Camera: NIDEK AFC-230. Fundus photo:
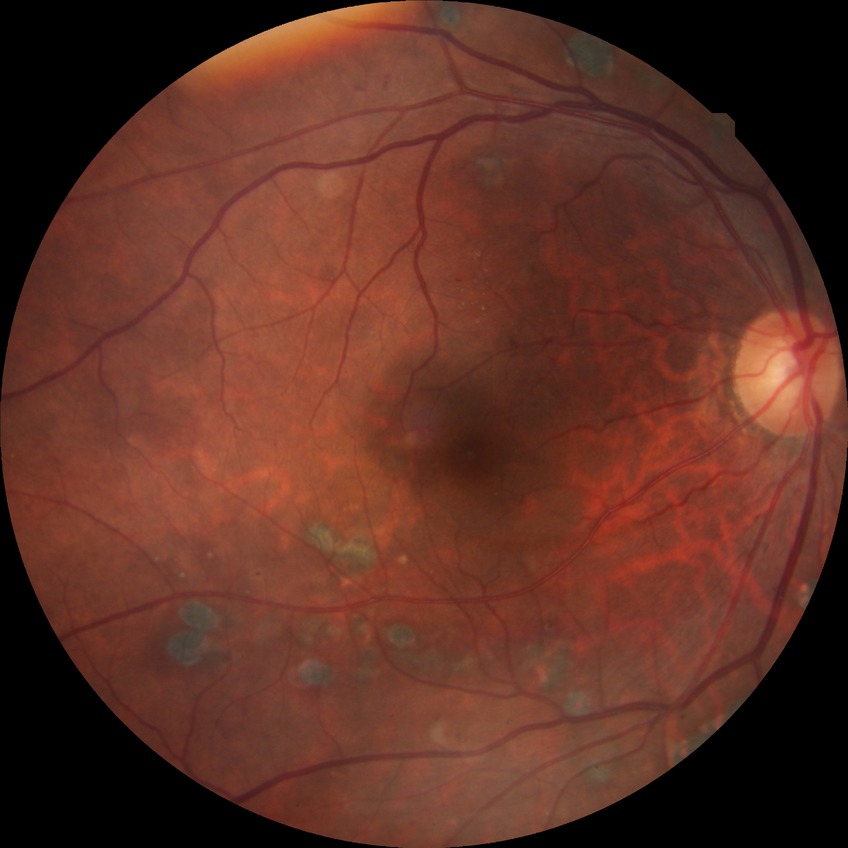 diabetic retinopathy (DR)@proliferative diabetic retinopathy (PDR).